Portable fundus camera image: 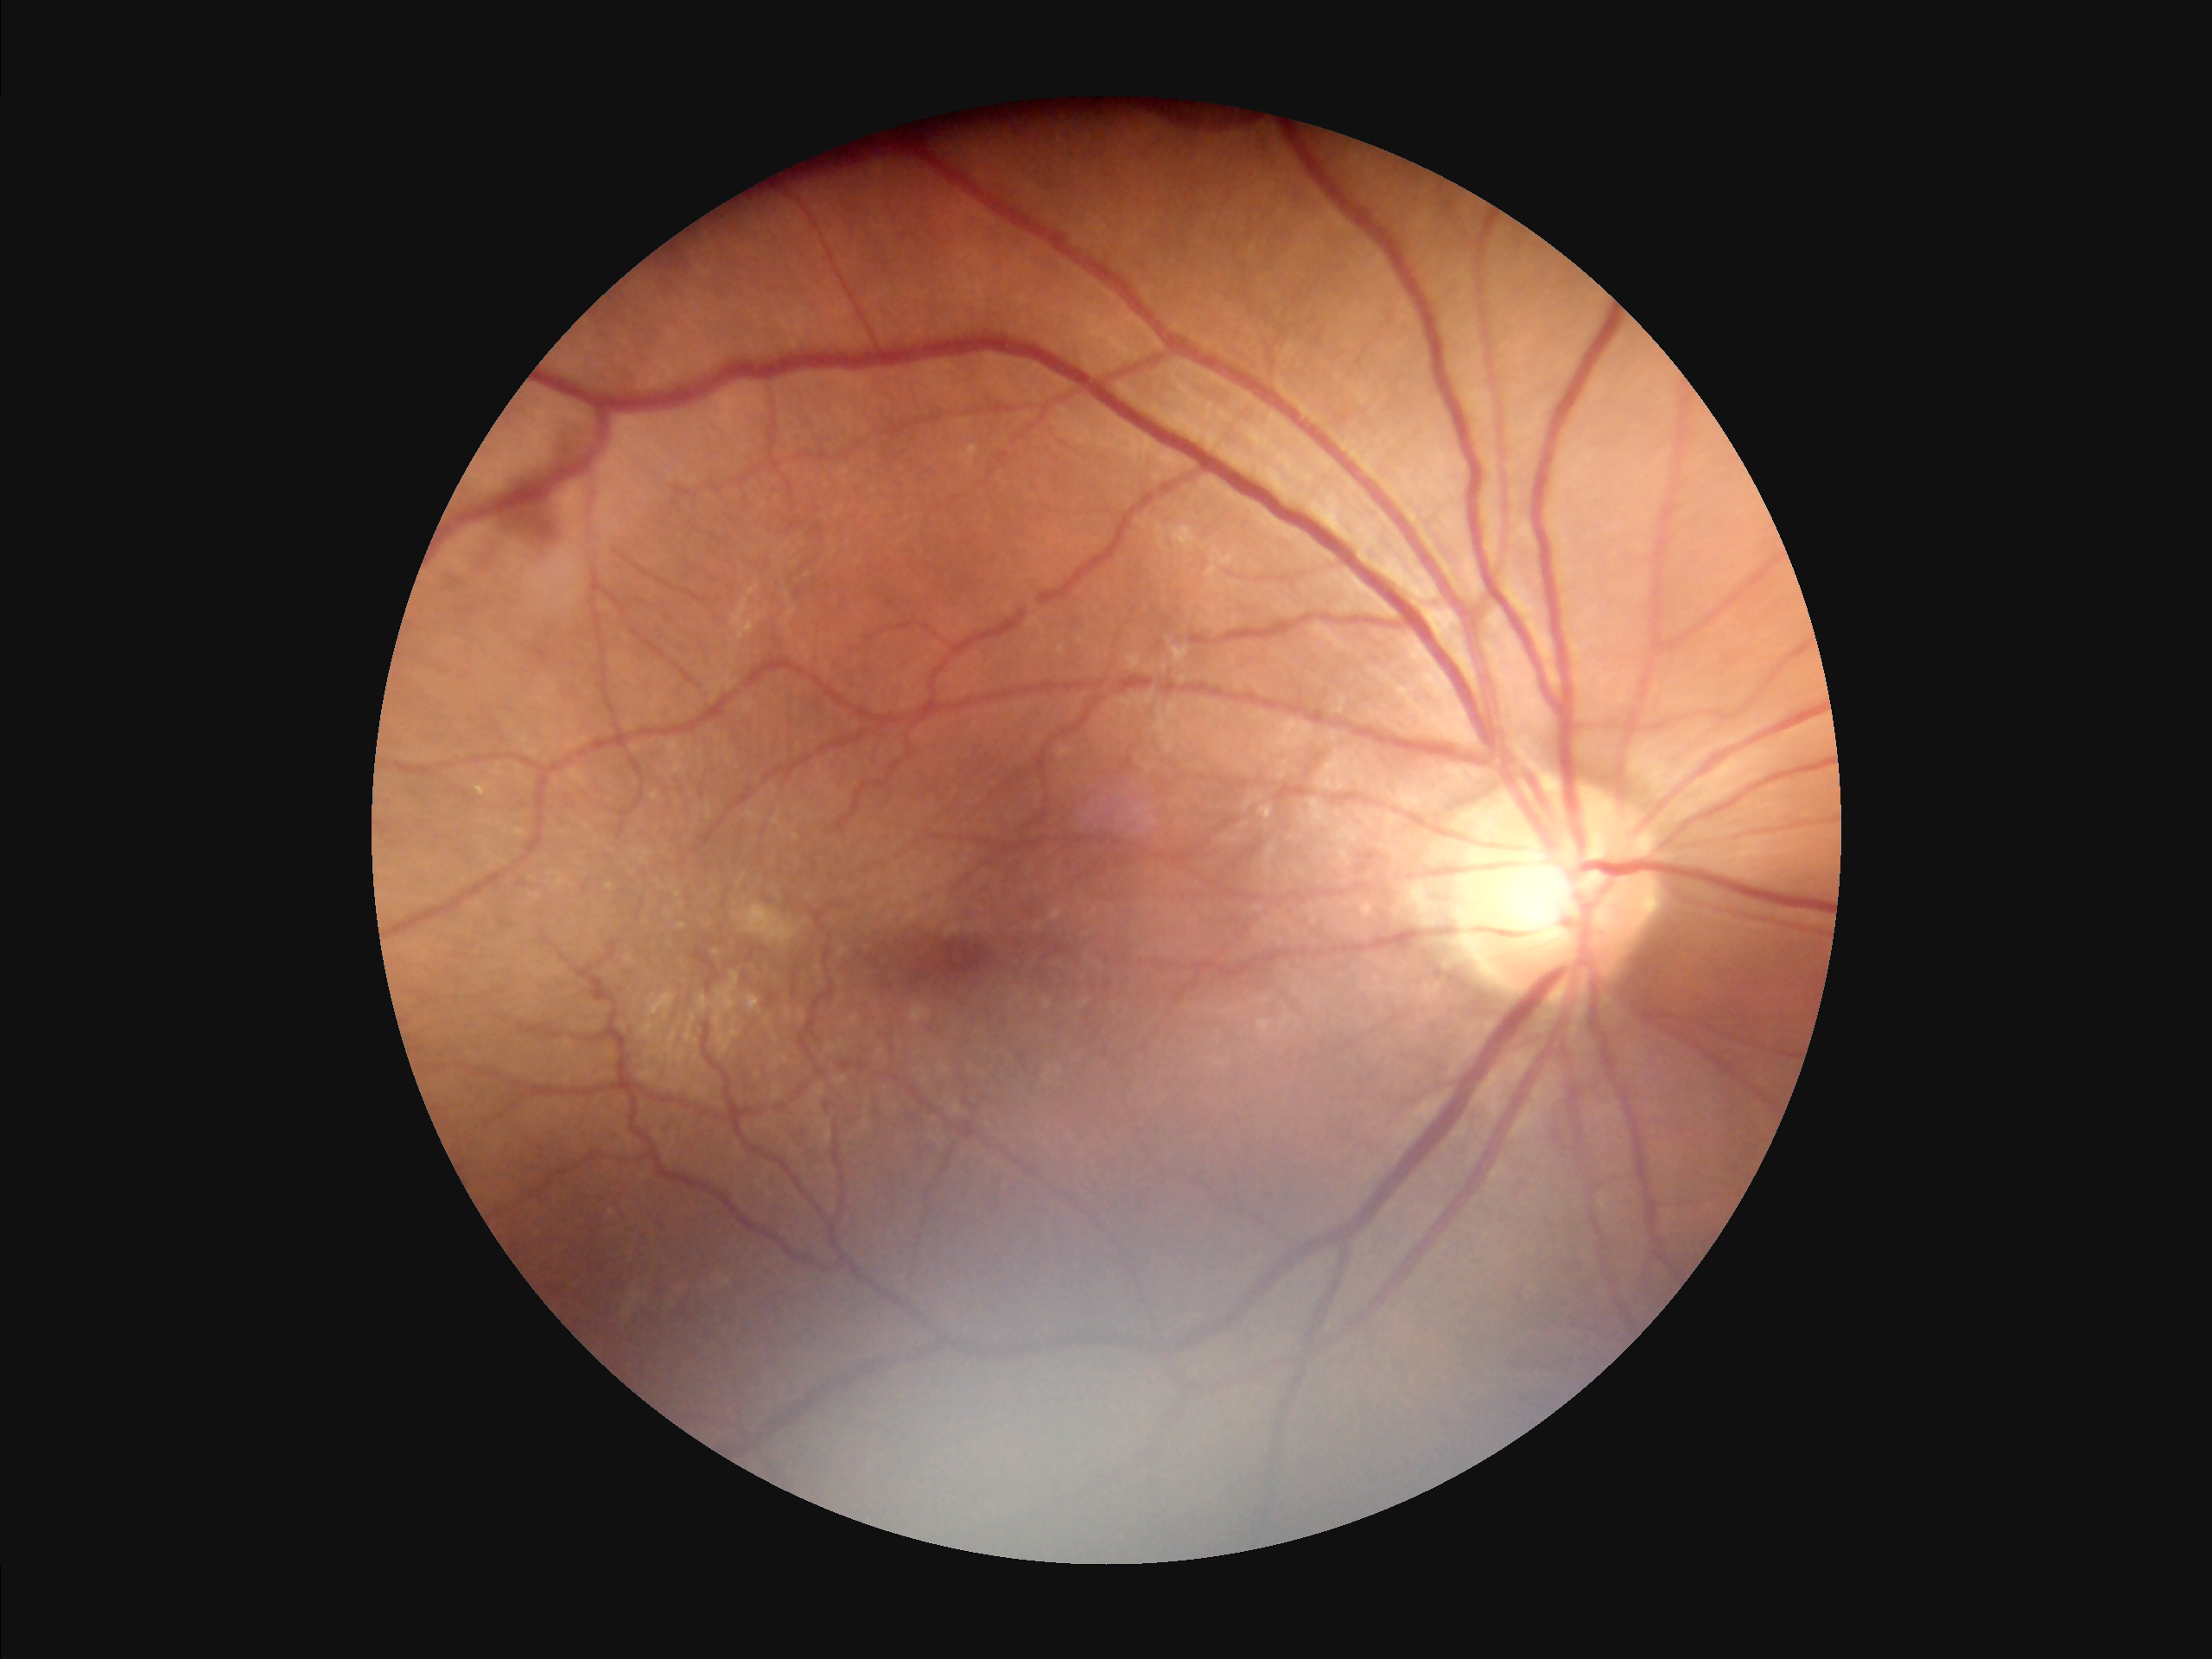

Quality assessment: illumination/color: inadequate, with uneven exposure or color distortion | contrast: wide intensity range, structures distinguishable | sharpness: clear with no noticeable blur.